FOV: 50 degrees
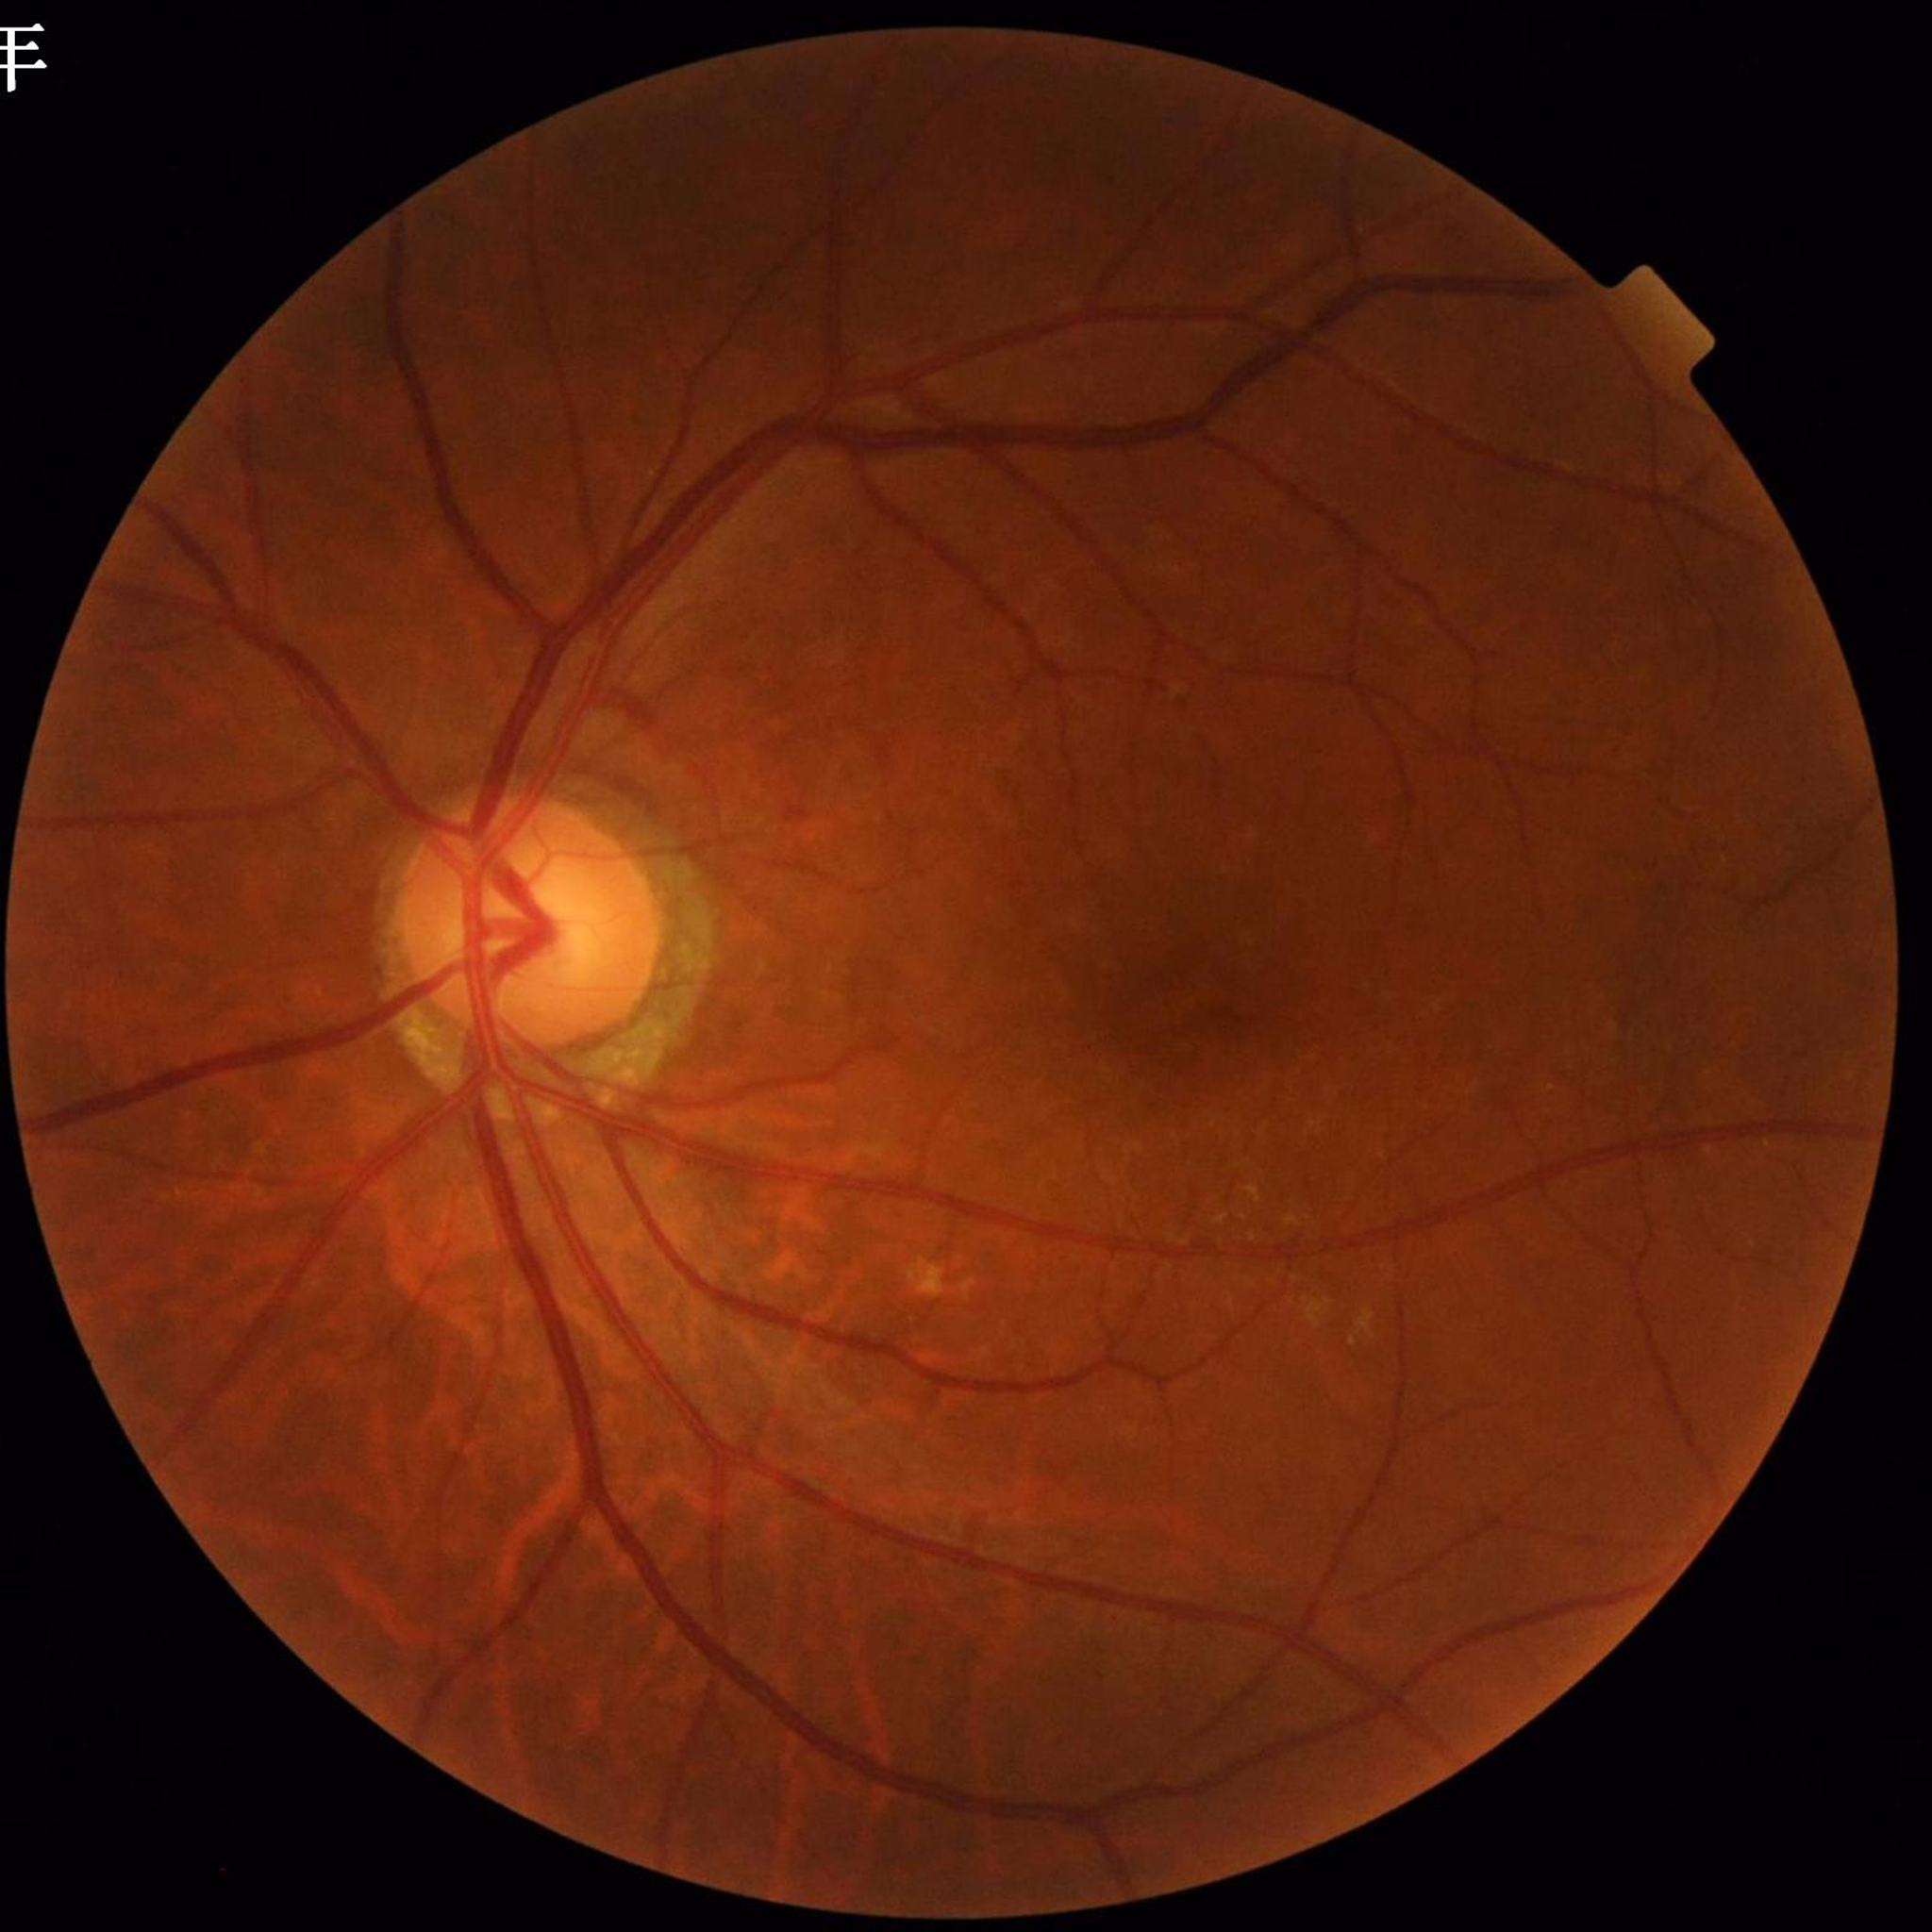

Quality: contrast adequate, no blur, illumination and color satisfactory. Diagnosed with diabetic retinopathy.